Color fundus photograph. 45° FOV. 1932 x 1932 pixels.
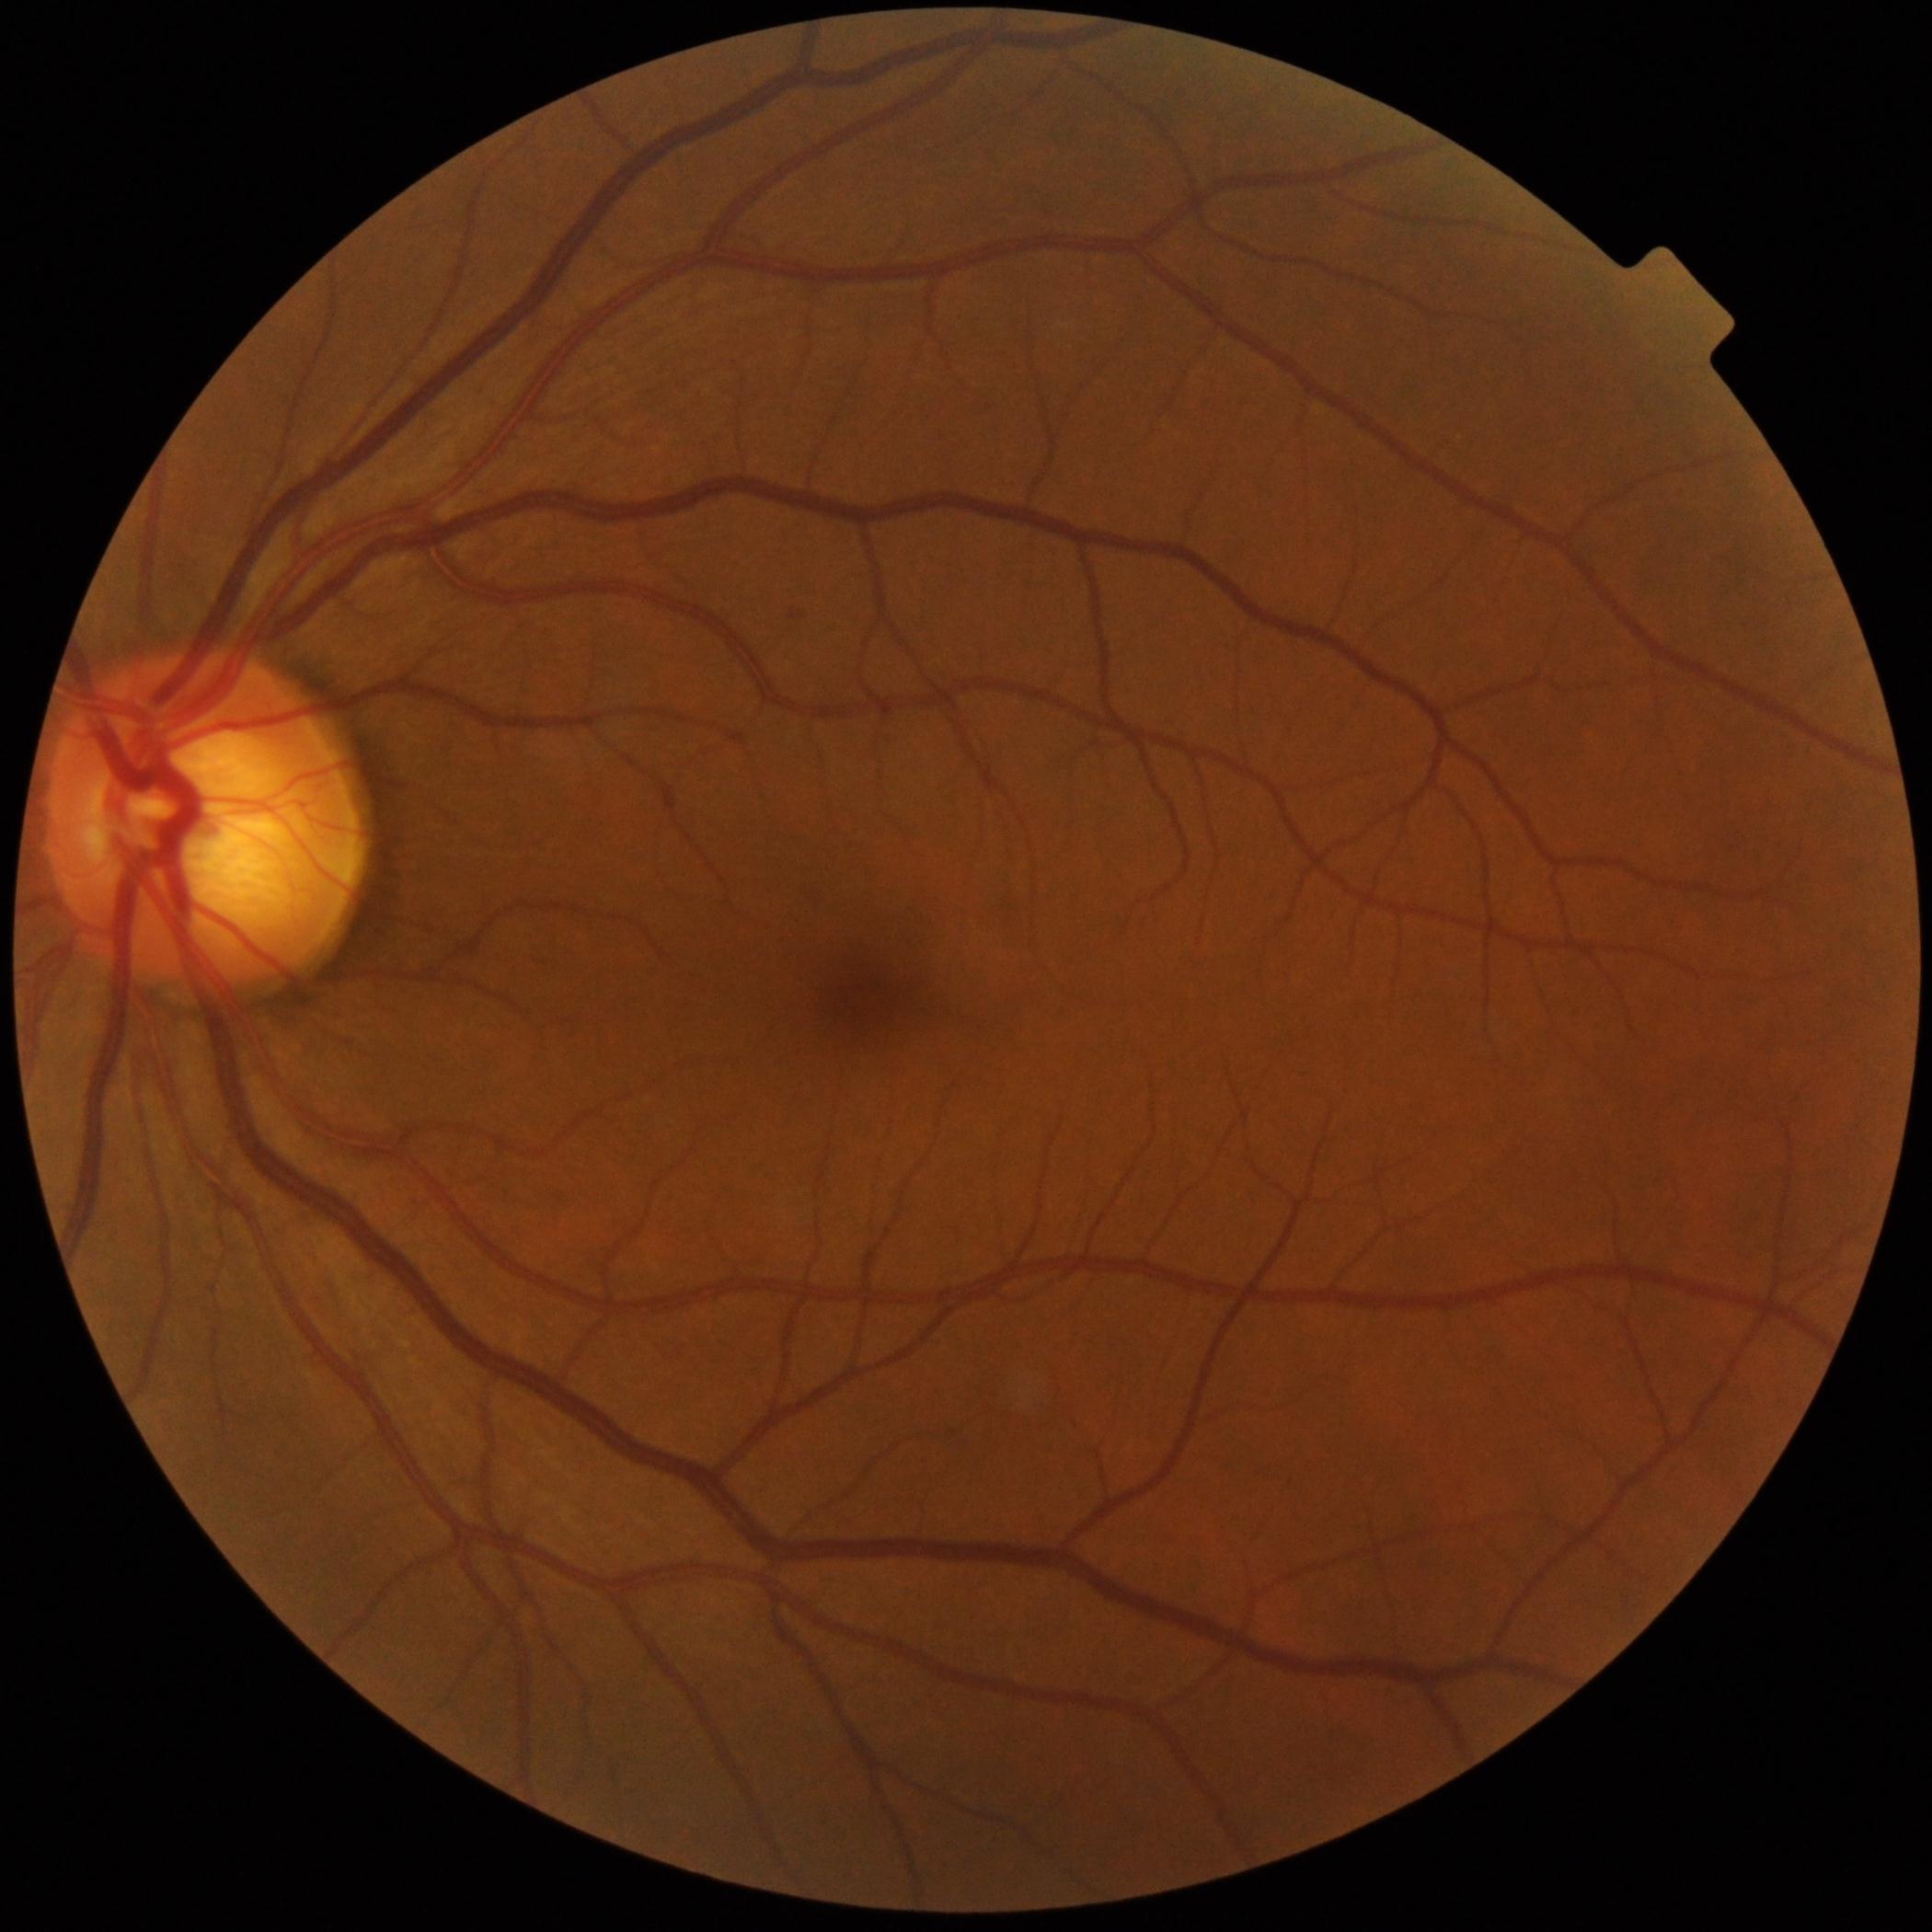
DR grade is mild NPDR (1).